Color fundus image; 2352 by 1568 pixels.
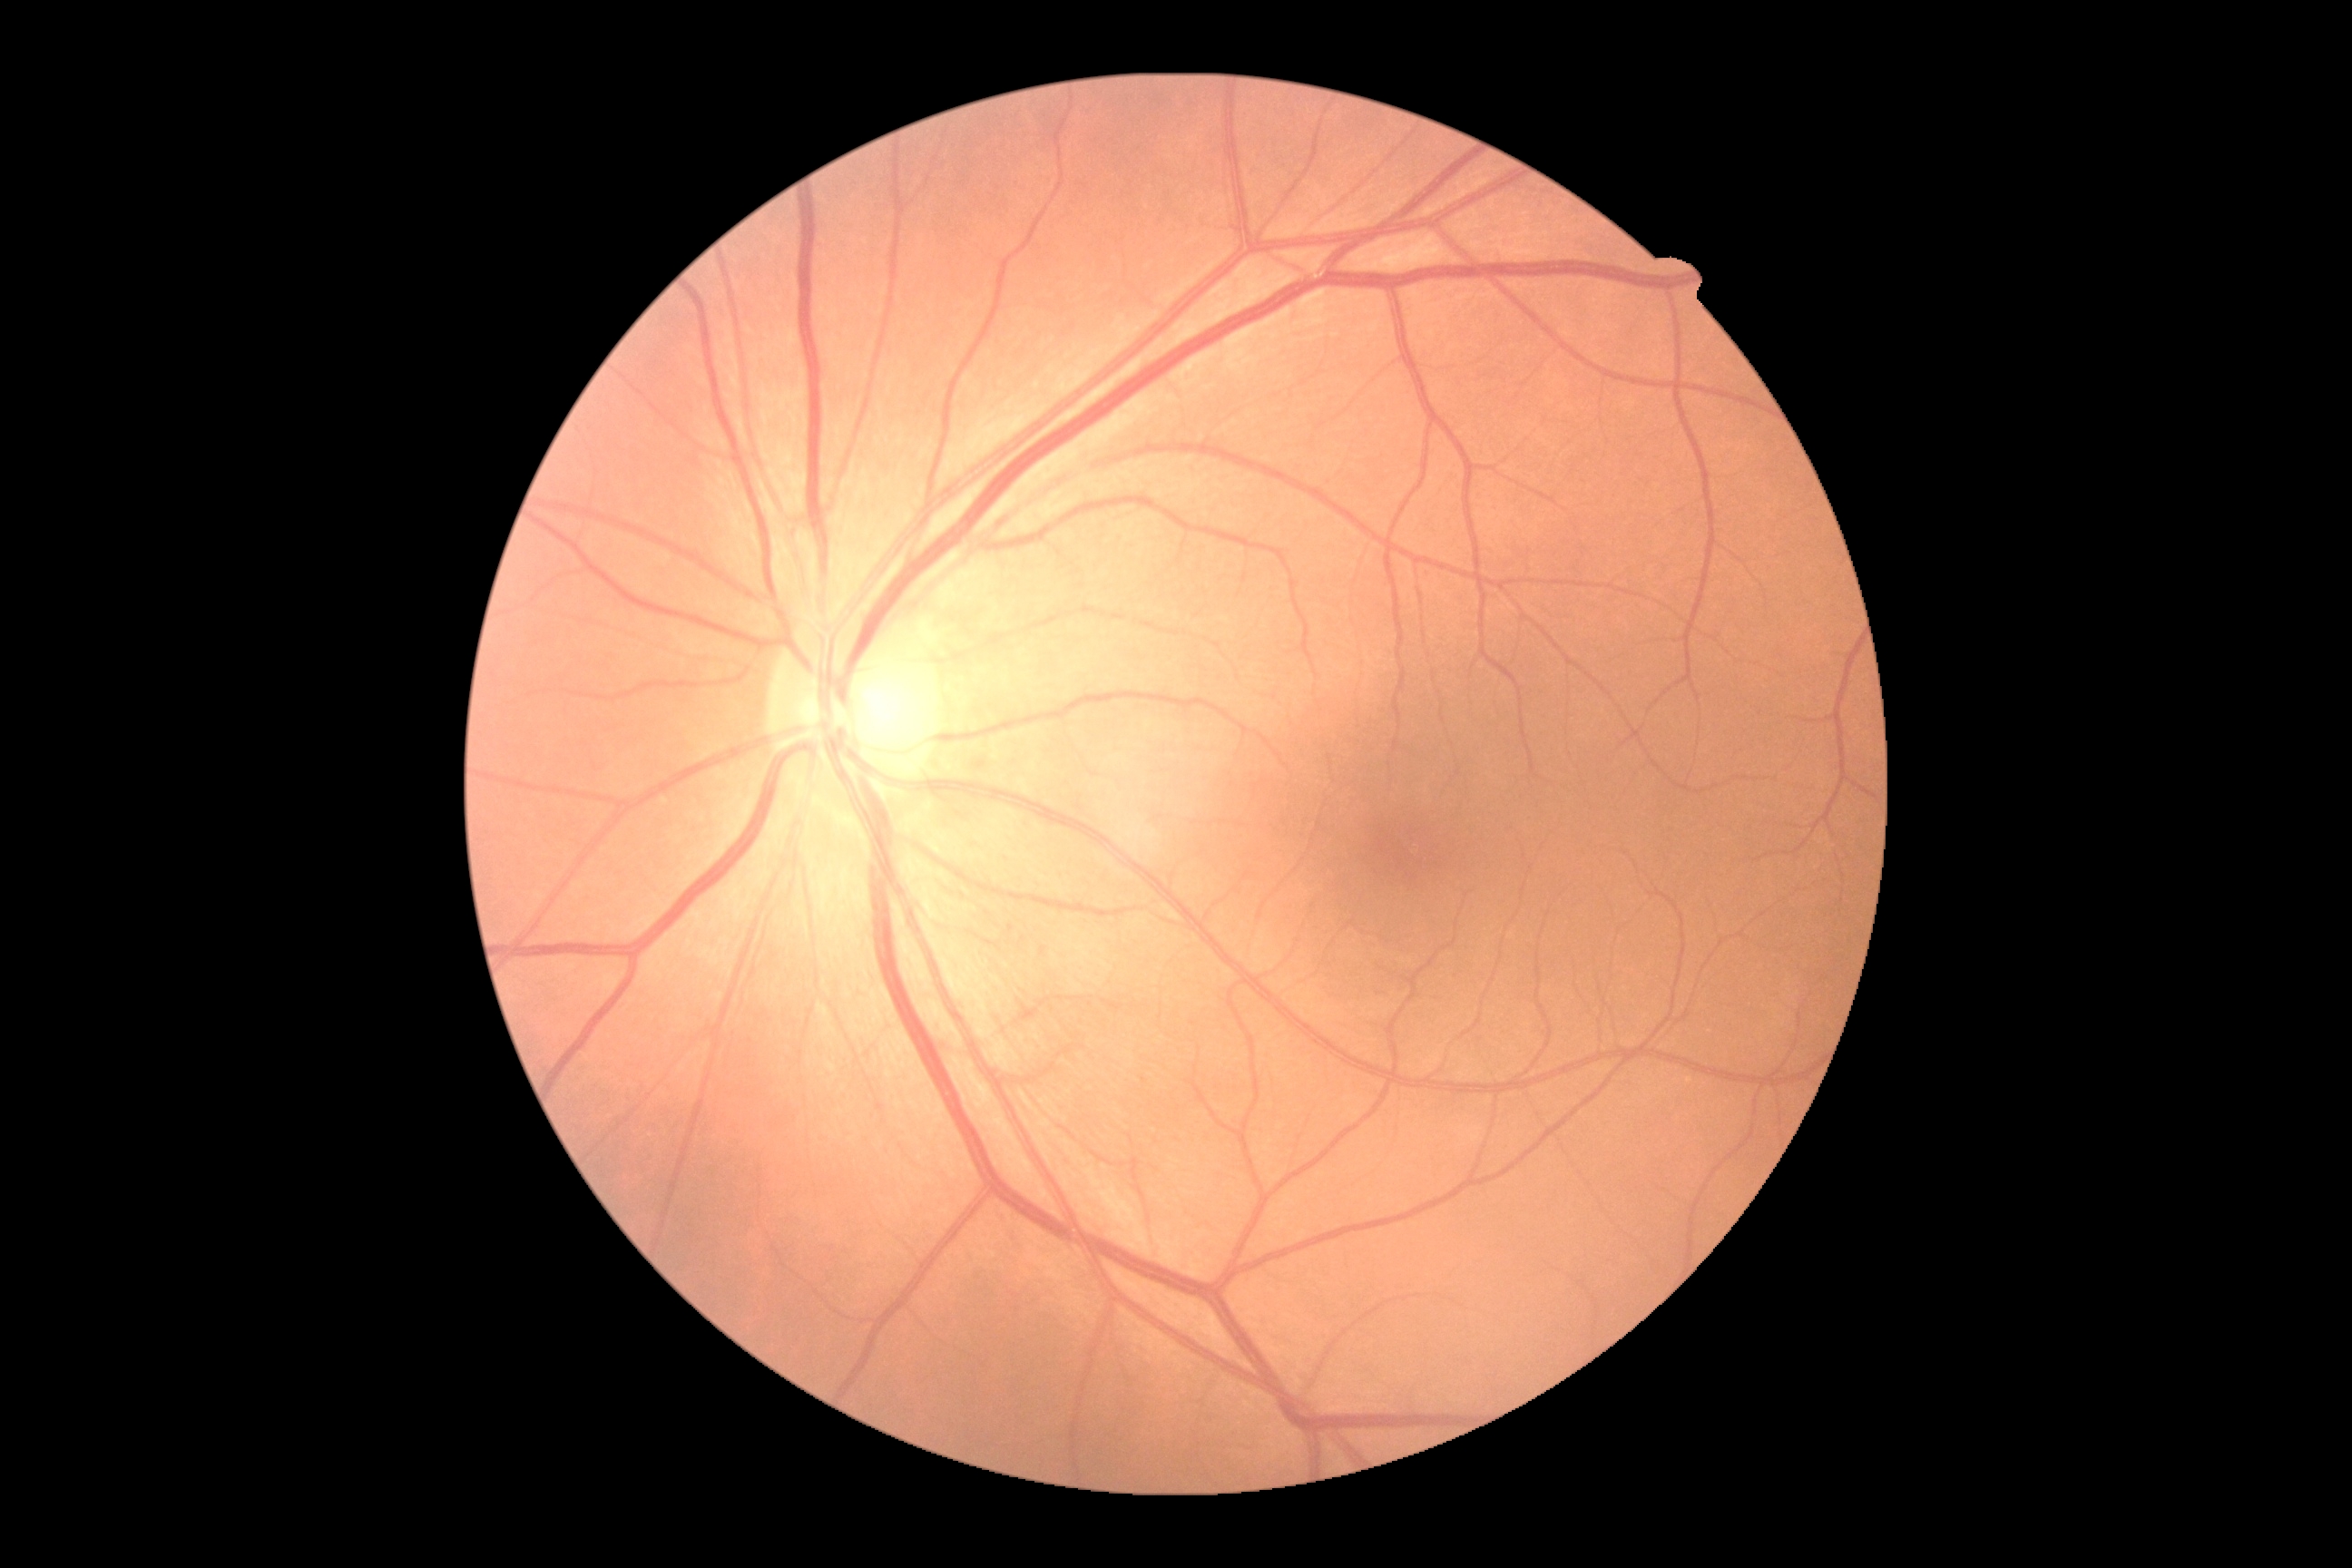
Findings:
* retinopathy grade: 0 (no apparent retinopathy) — no visible signs of diabetic retinopathy
* DR impression: no signs of DR